Color fundus photograph, camera: Topcon TRC-50DX:
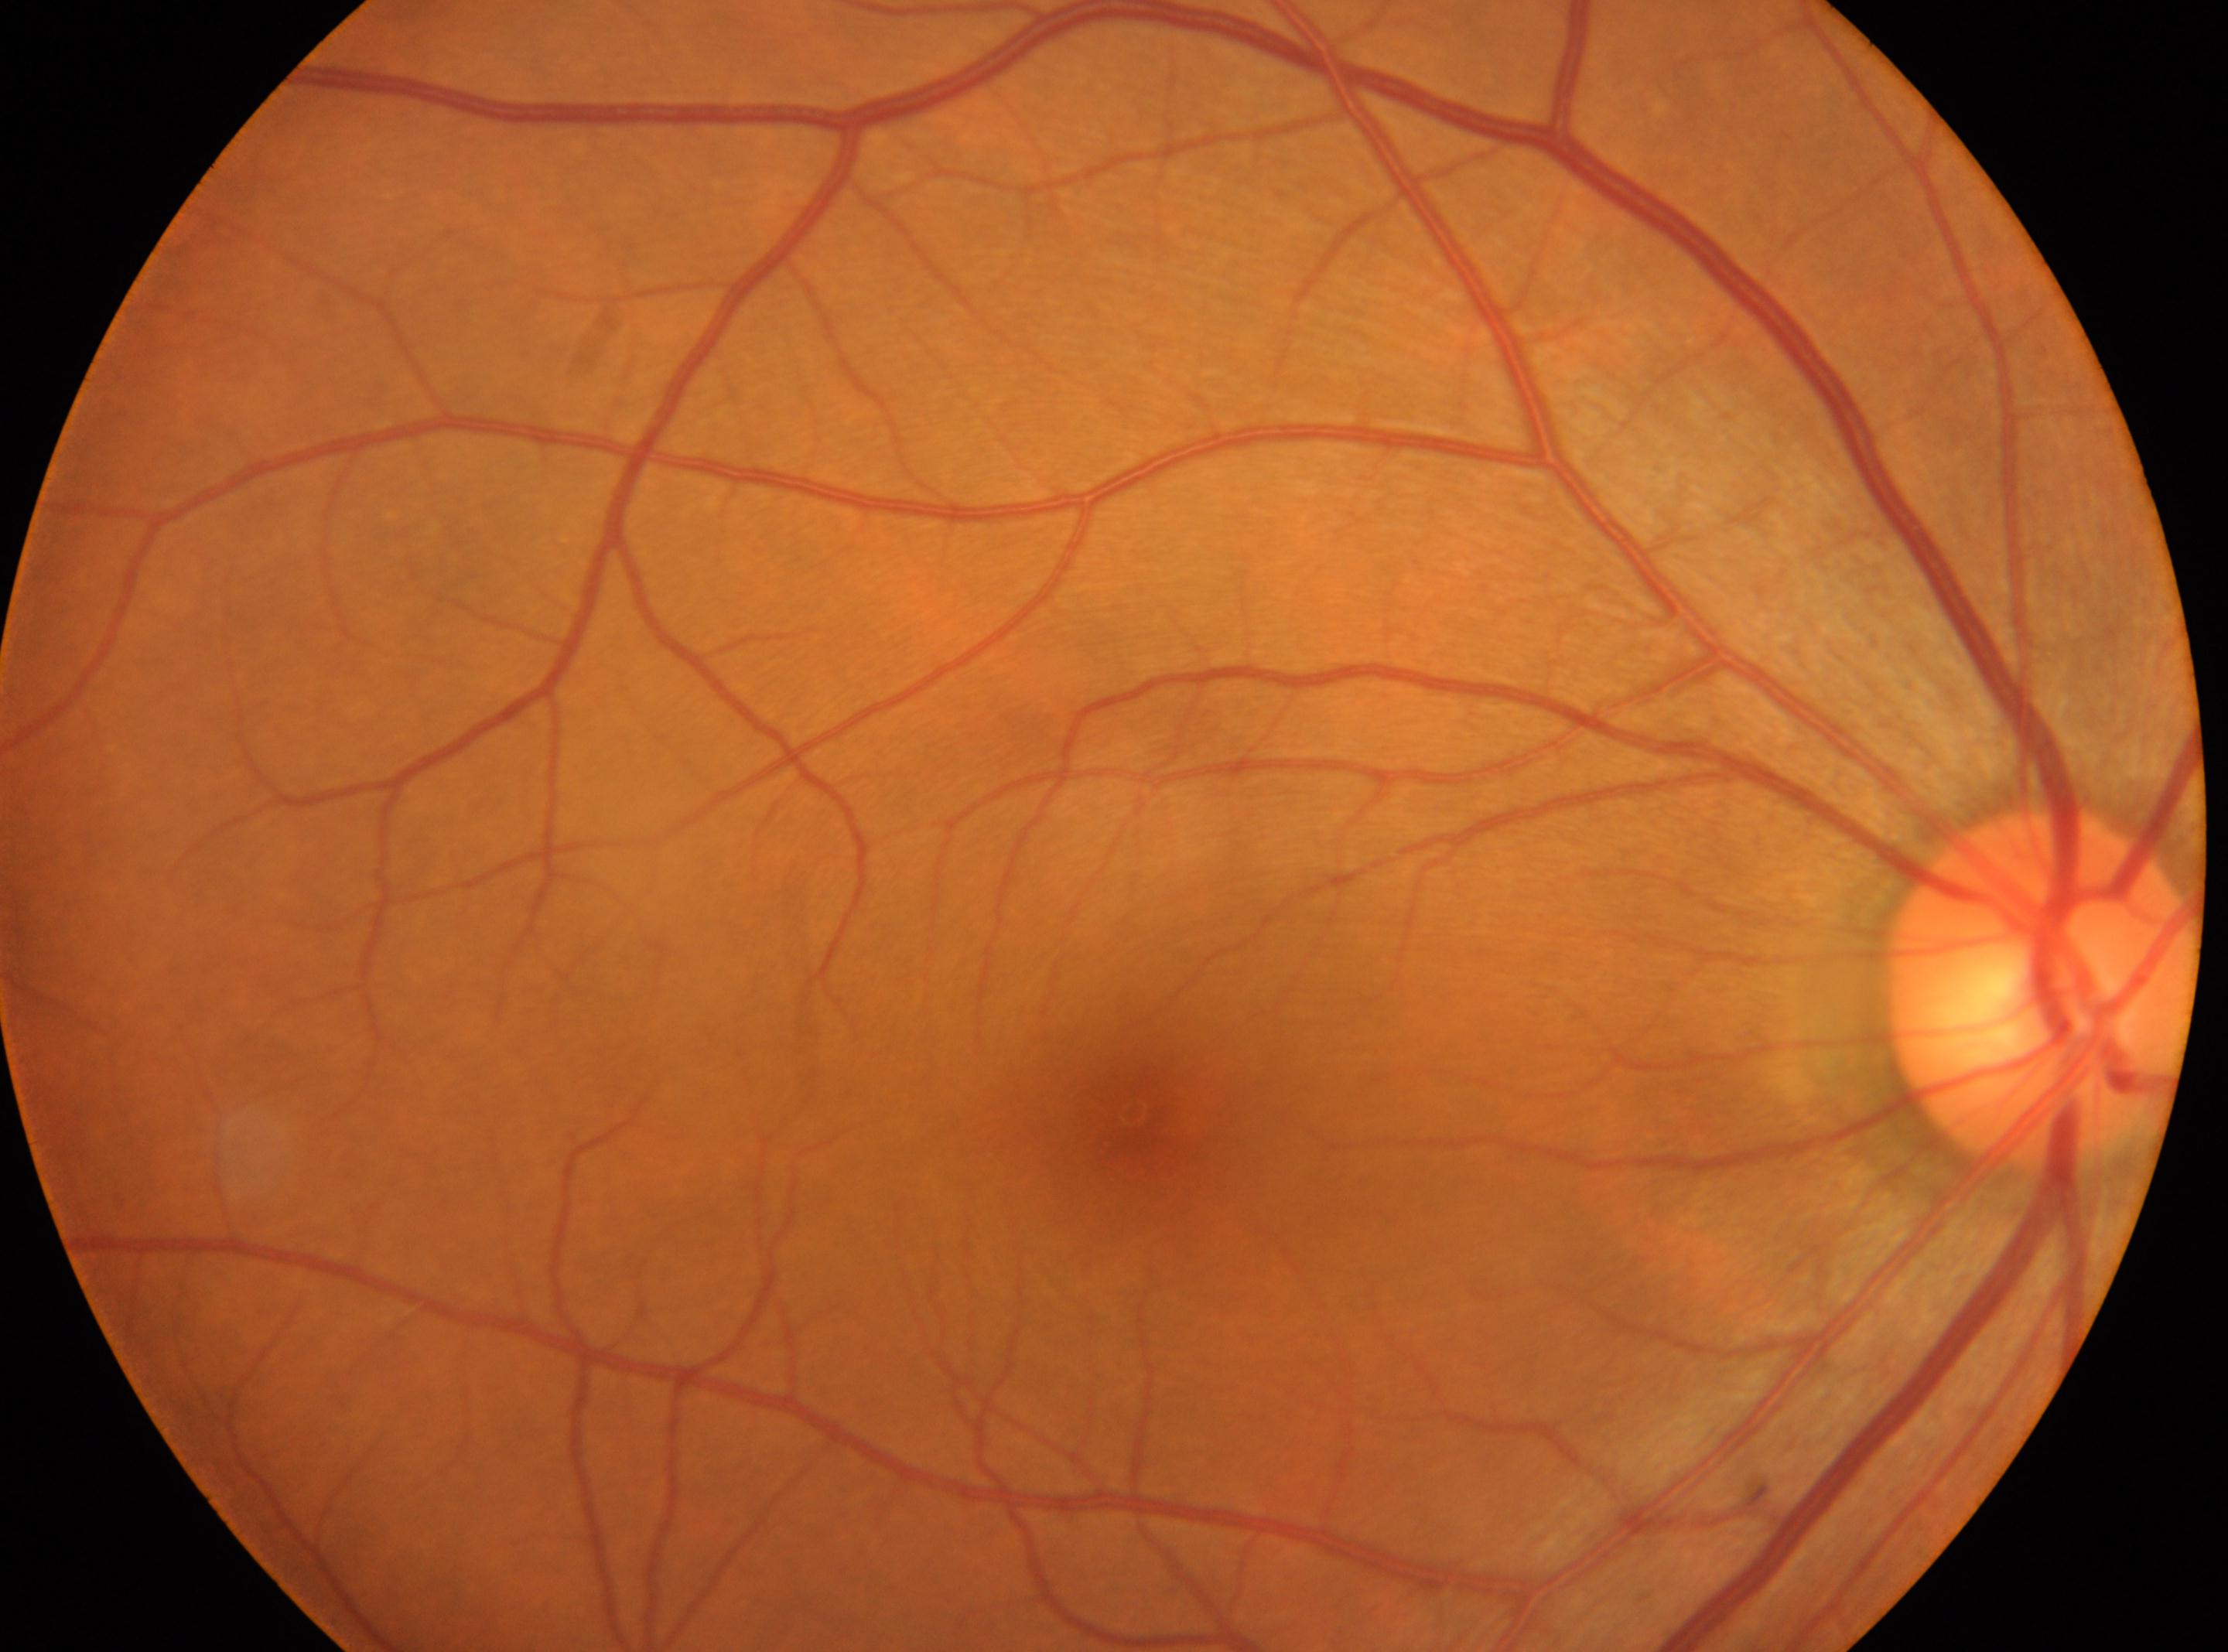

Eye: OD.
Foveal center located at (1134, 1111).
No diabetic retinal disease findings.
DR stage is 0.
Optic nerve head: (2042, 985).